CFP; centered on the optic disc; 61-year-old patient: 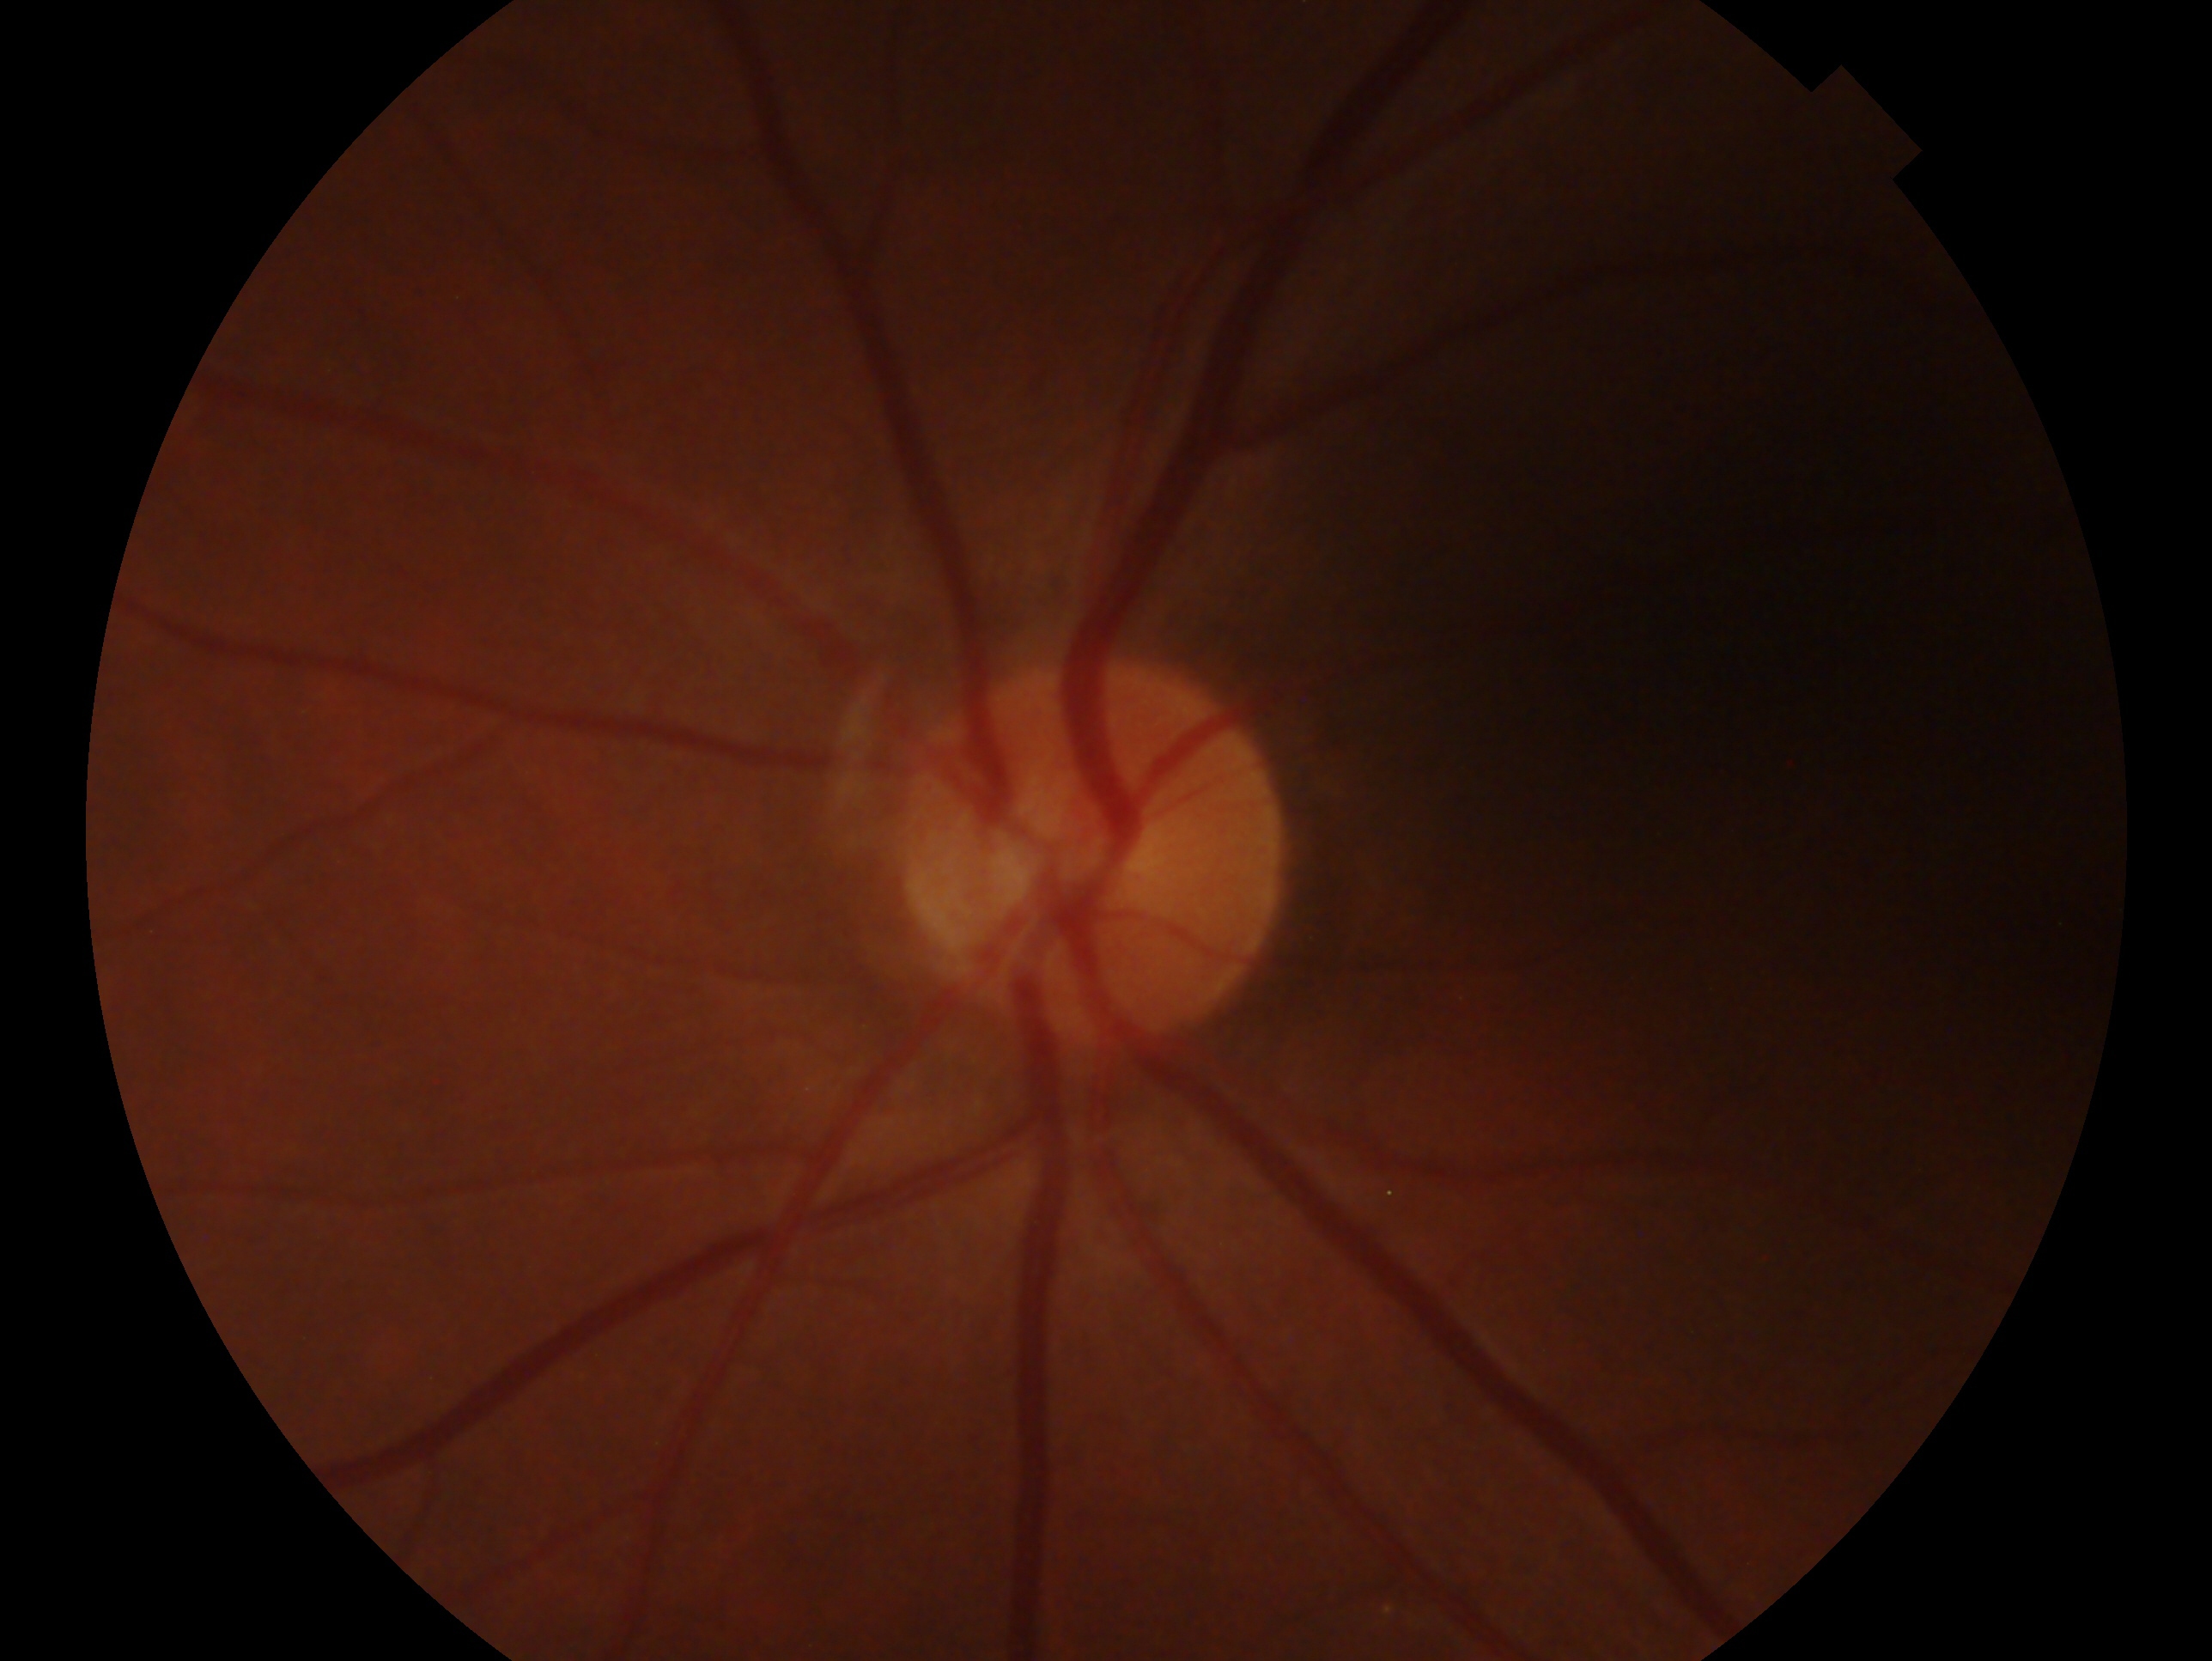 Clinical classification: negative for glaucoma — no clinical evidence of glaucoma in this eye. Eye: OS.